Davis DR grading:
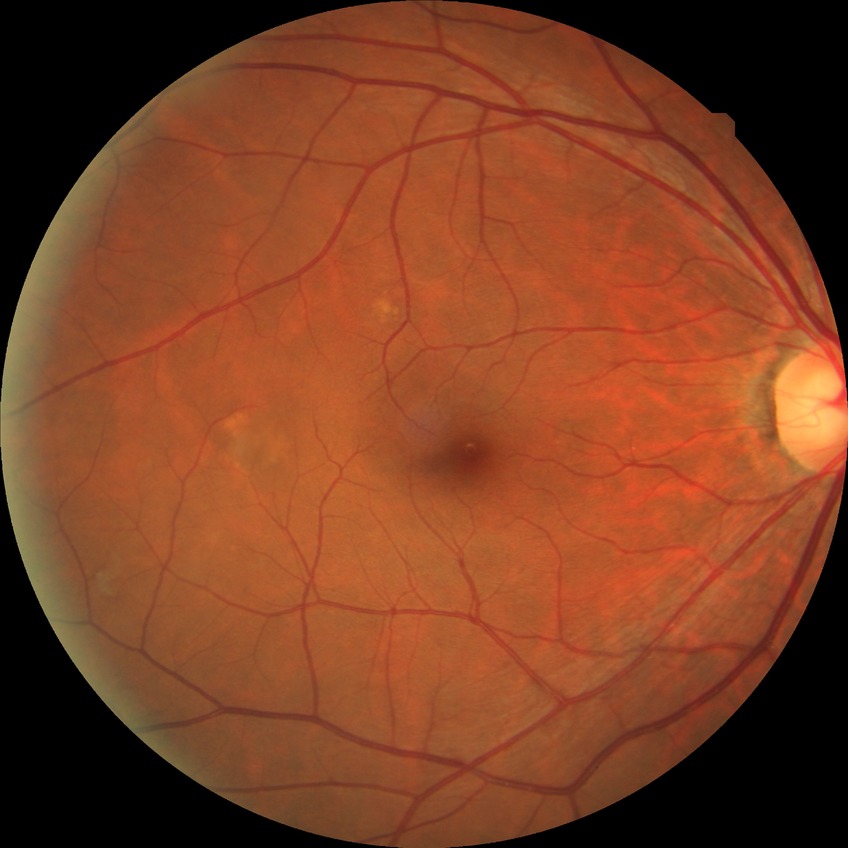

Diabetic retinopathy stage is no diabetic retinopathy.